Color fundus photograph:
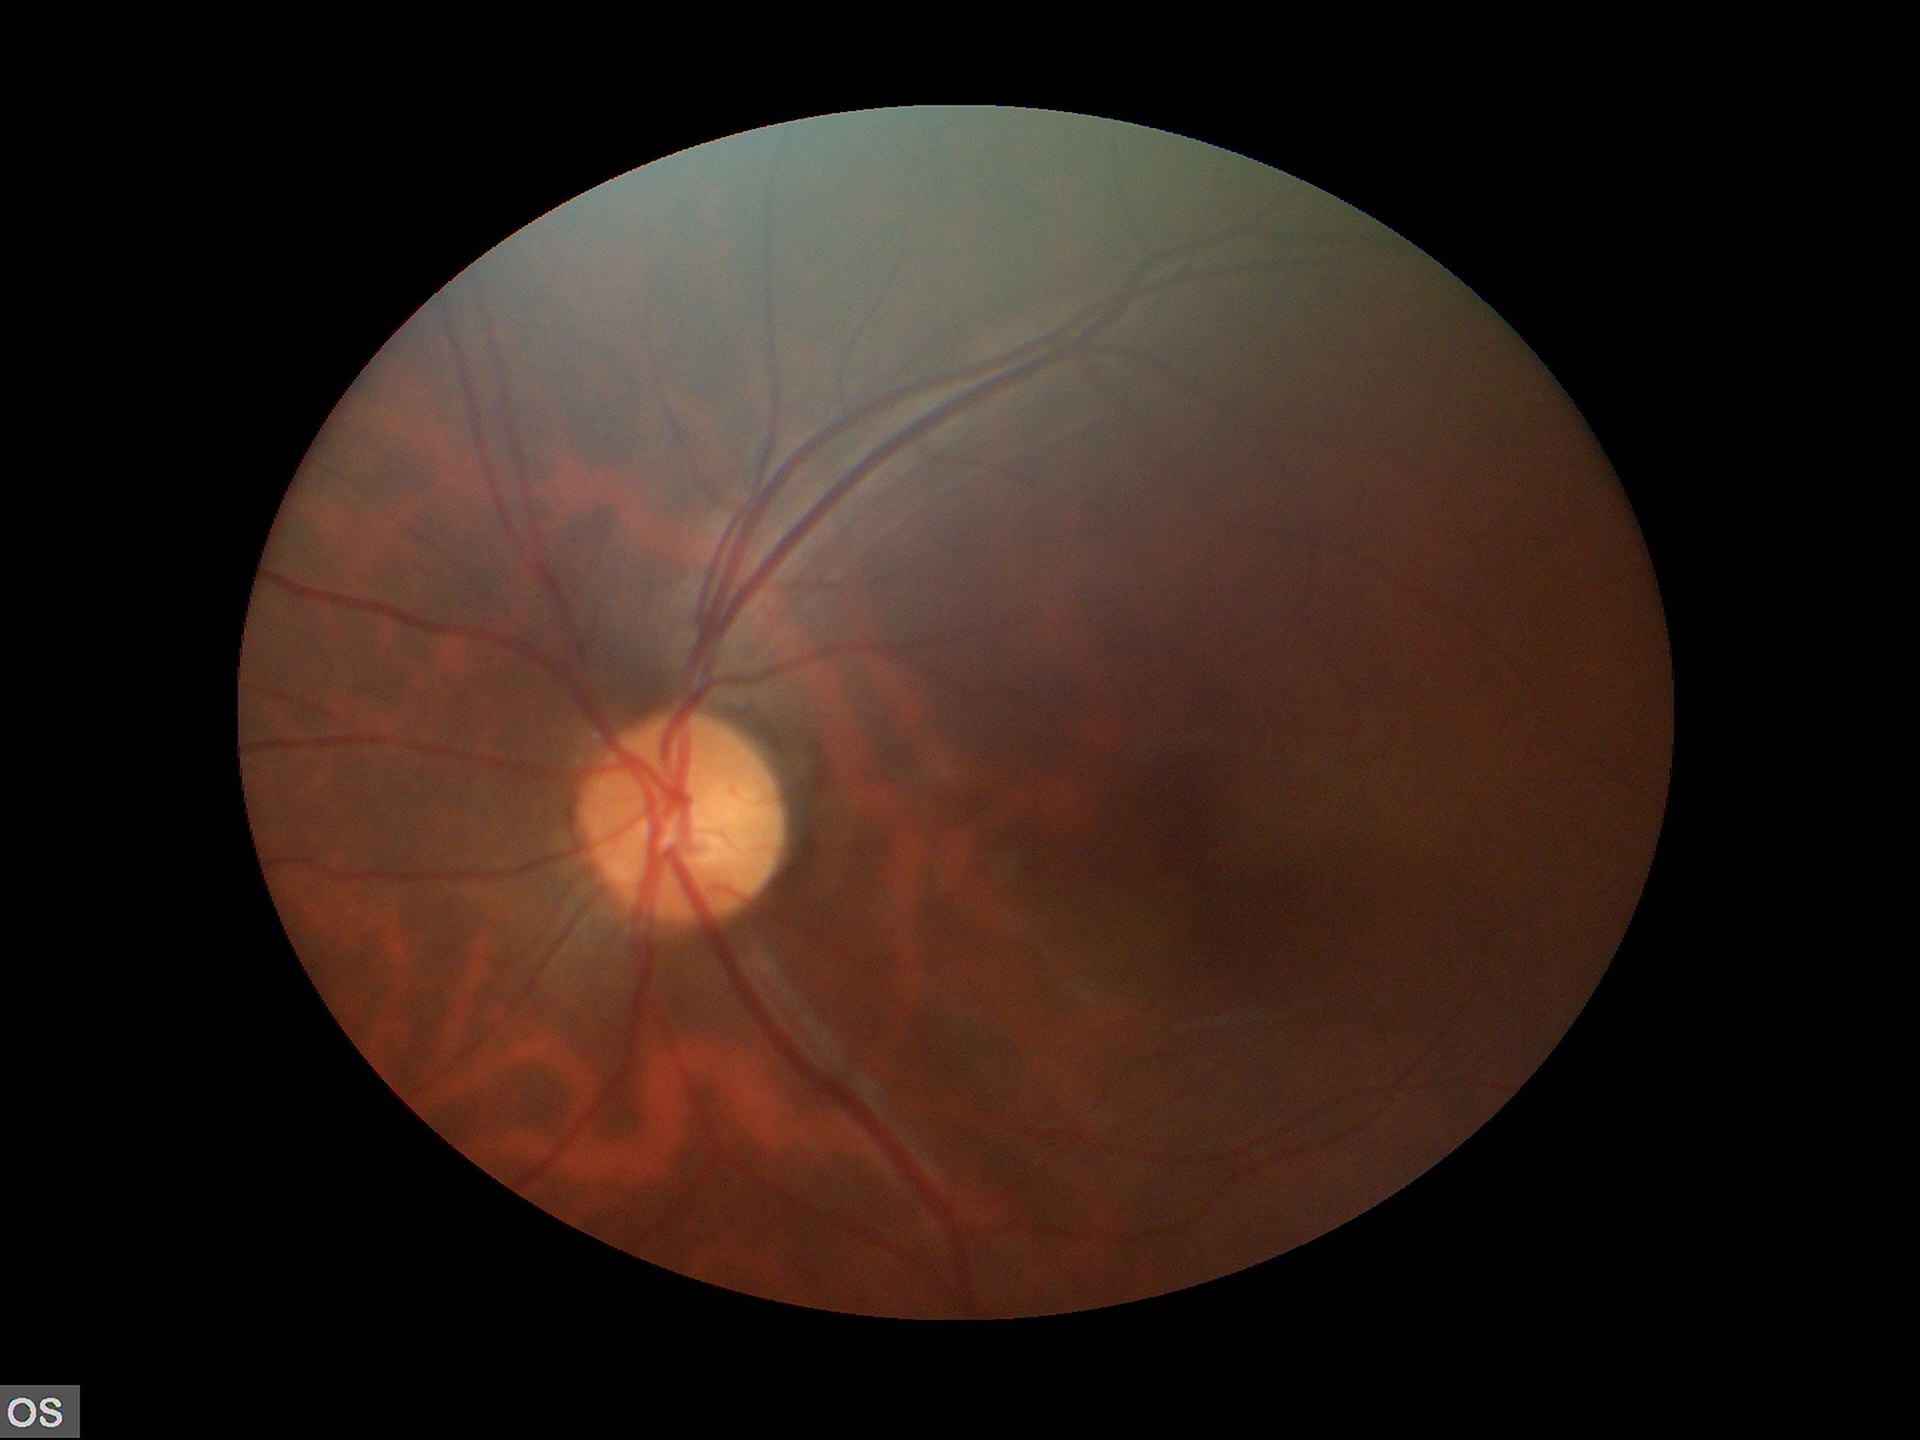
Vertical C/D ratio of 0.50.
Glaucoma impression: negative.
Area CDR: 0.27.